Wide-field fundus image from infant ROP screening. 100° field of view (Phoenix ICON):
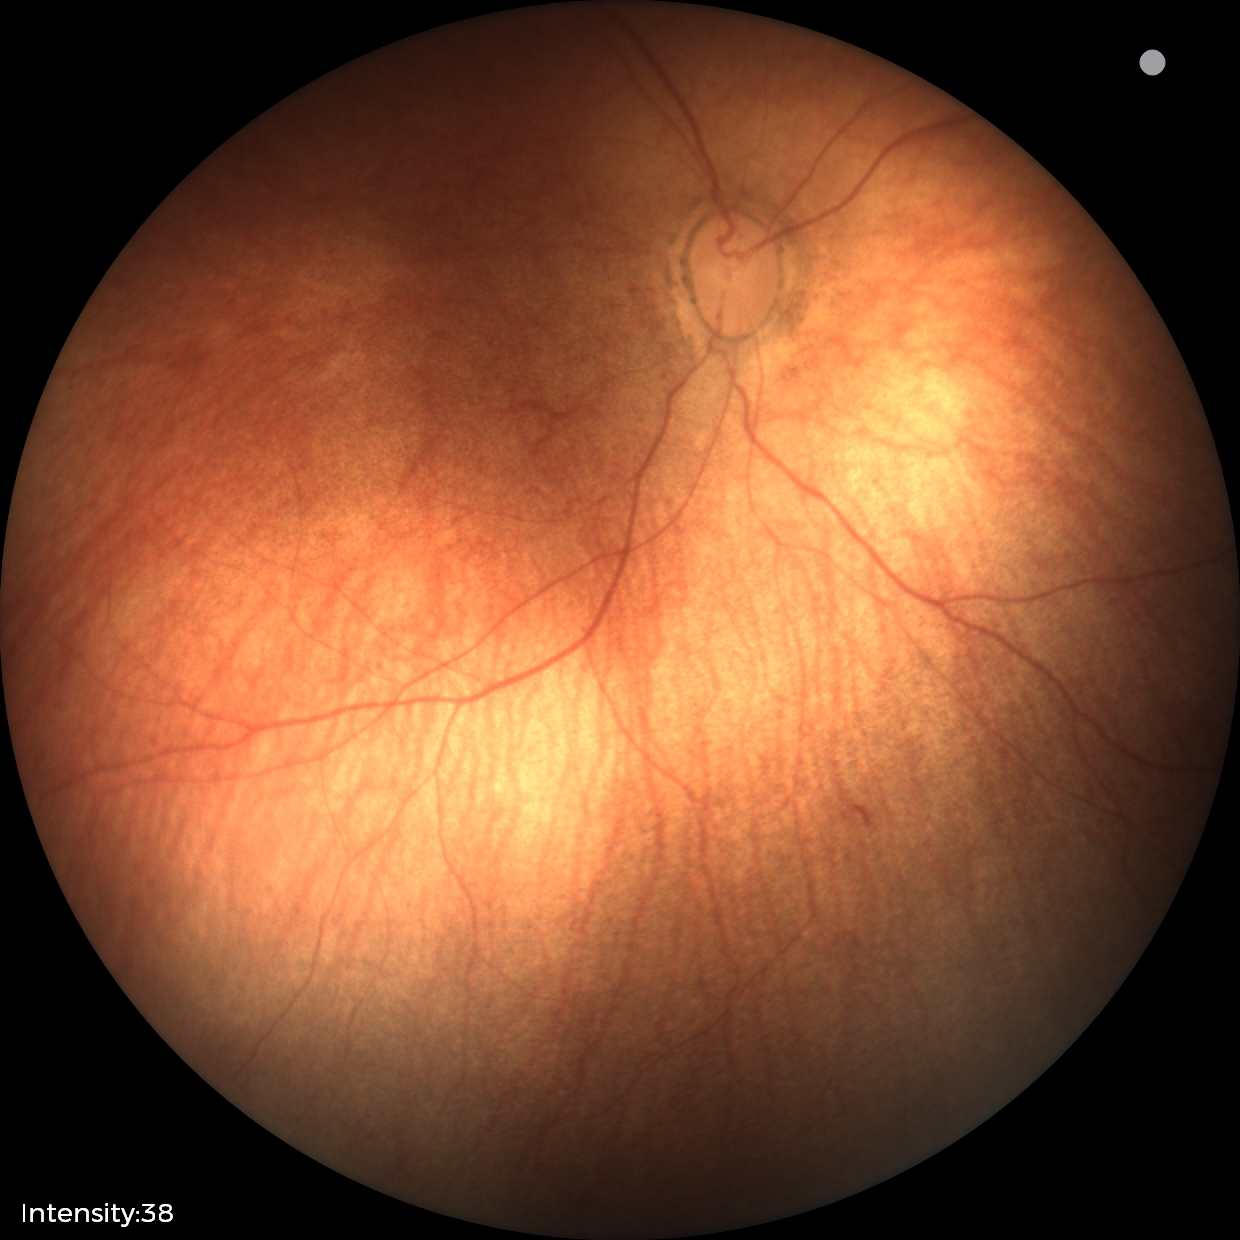
Physiological retinal appearance for postconceptual age.